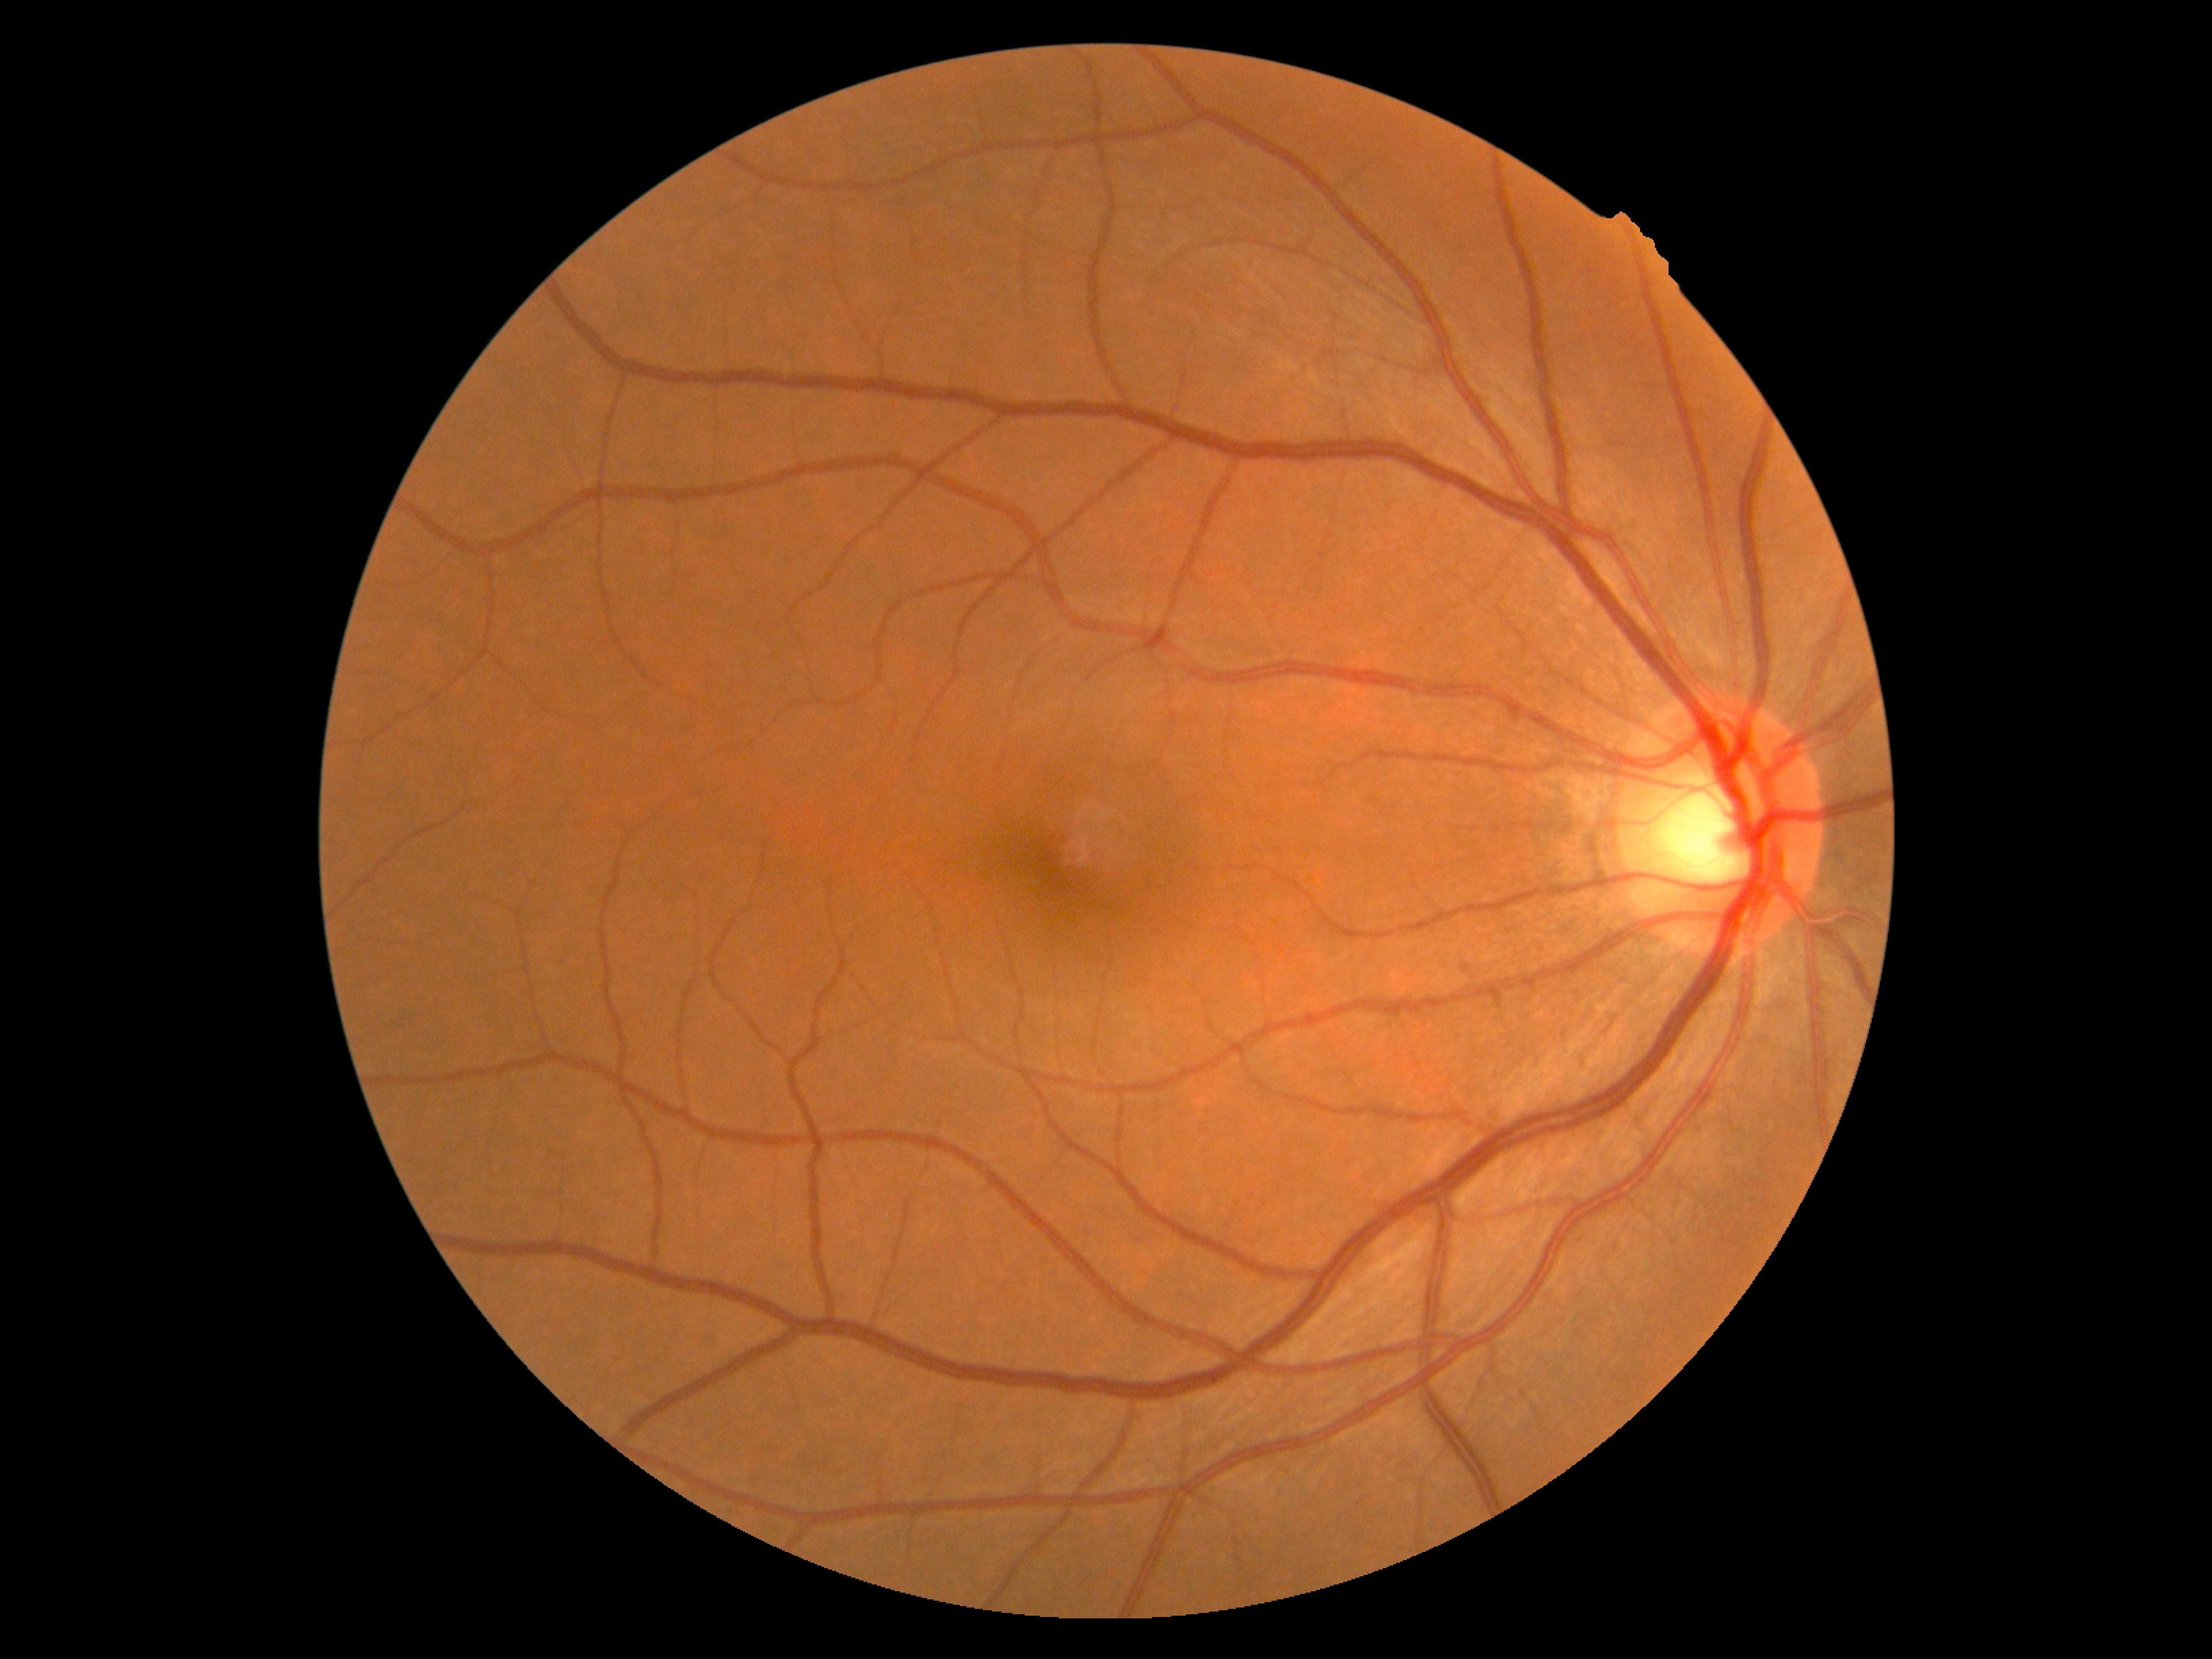 DR severity=0.